Wide-field fundus photograph from neonatal ROP screening · camera: Phoenix ICON (100° FOV) · 1240x1240px — 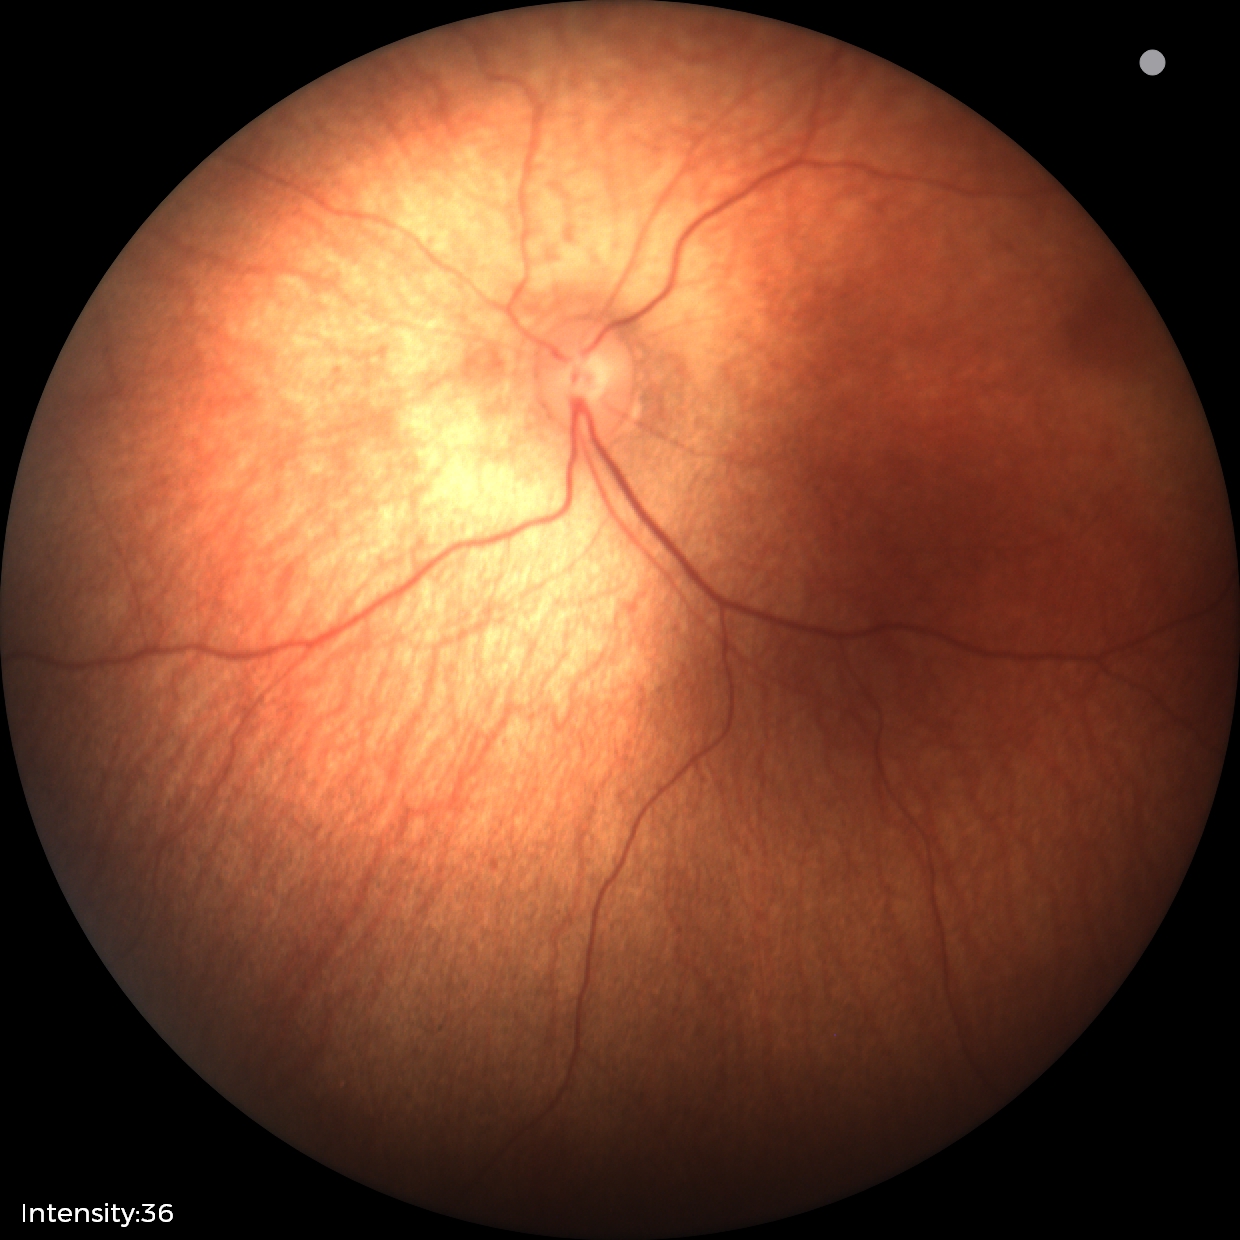
Screening diagnosis = physiological.